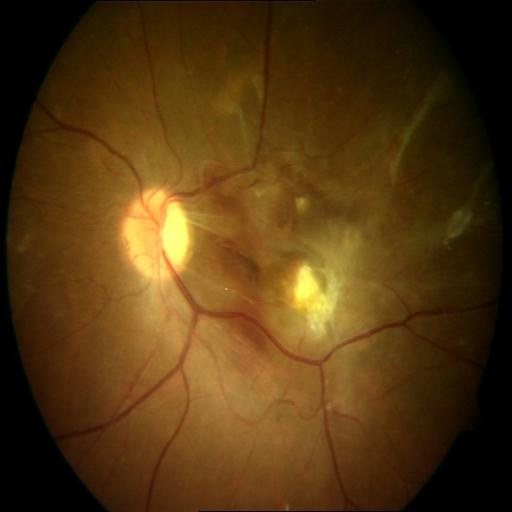

Diagnosis: retinal traction (RT).